Wide-field fundus photograph from neonatal ROP screening.
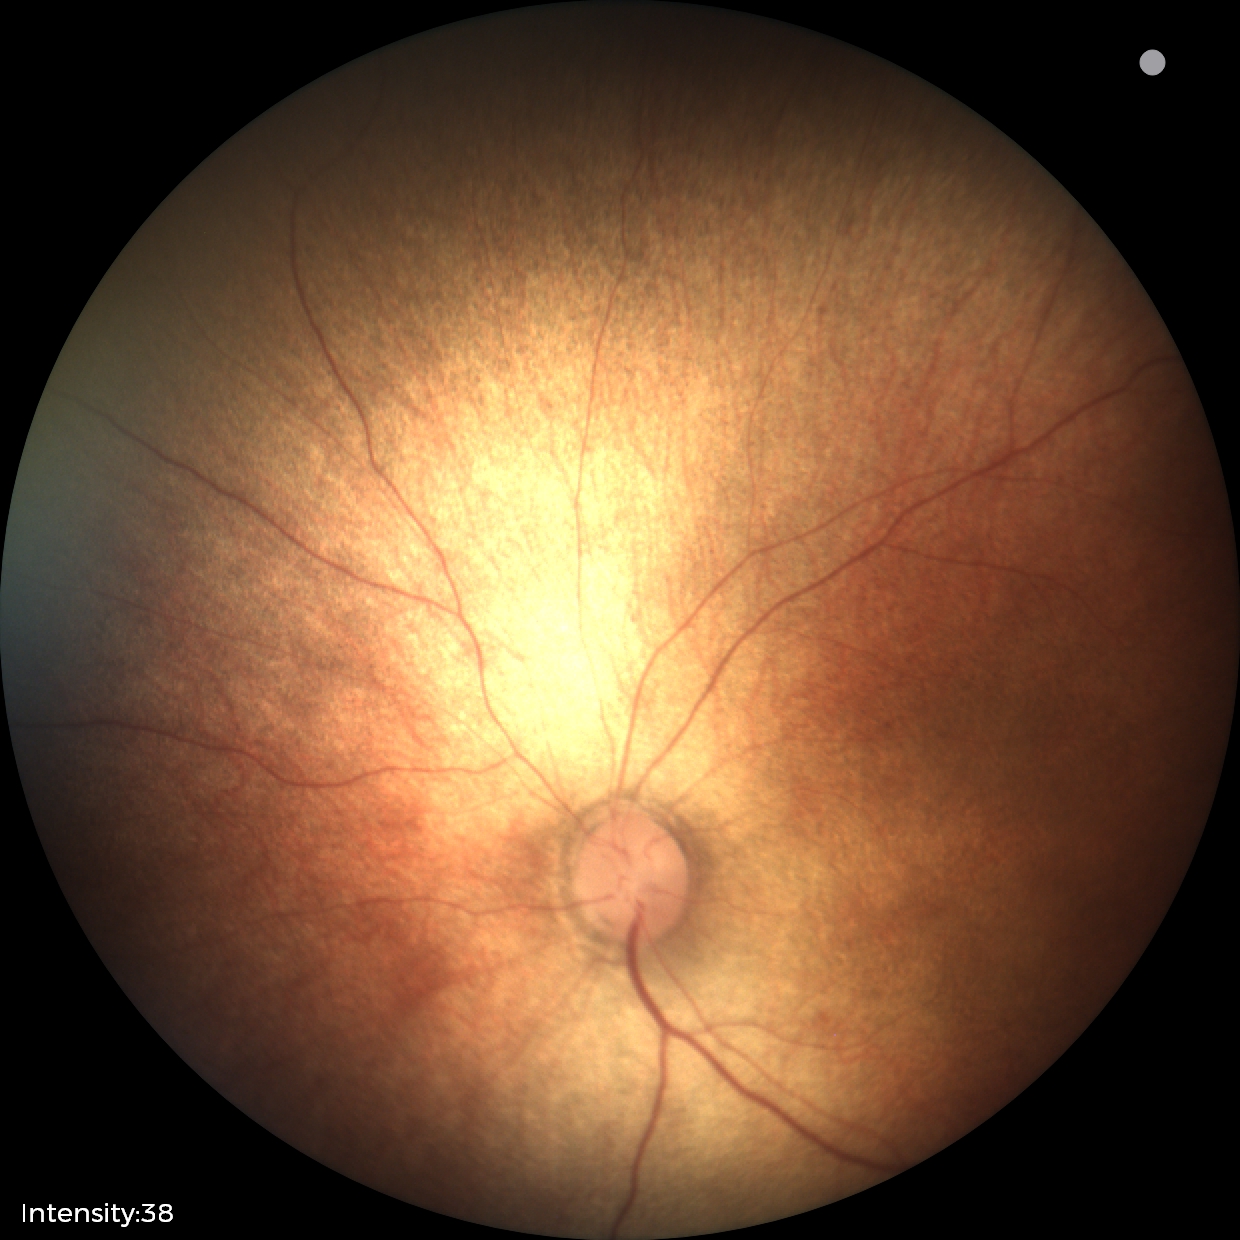 Q: What is the diagnosis from this examination?
A: normal retinal appearance